45° field of view. 1932 by 1916 pixels
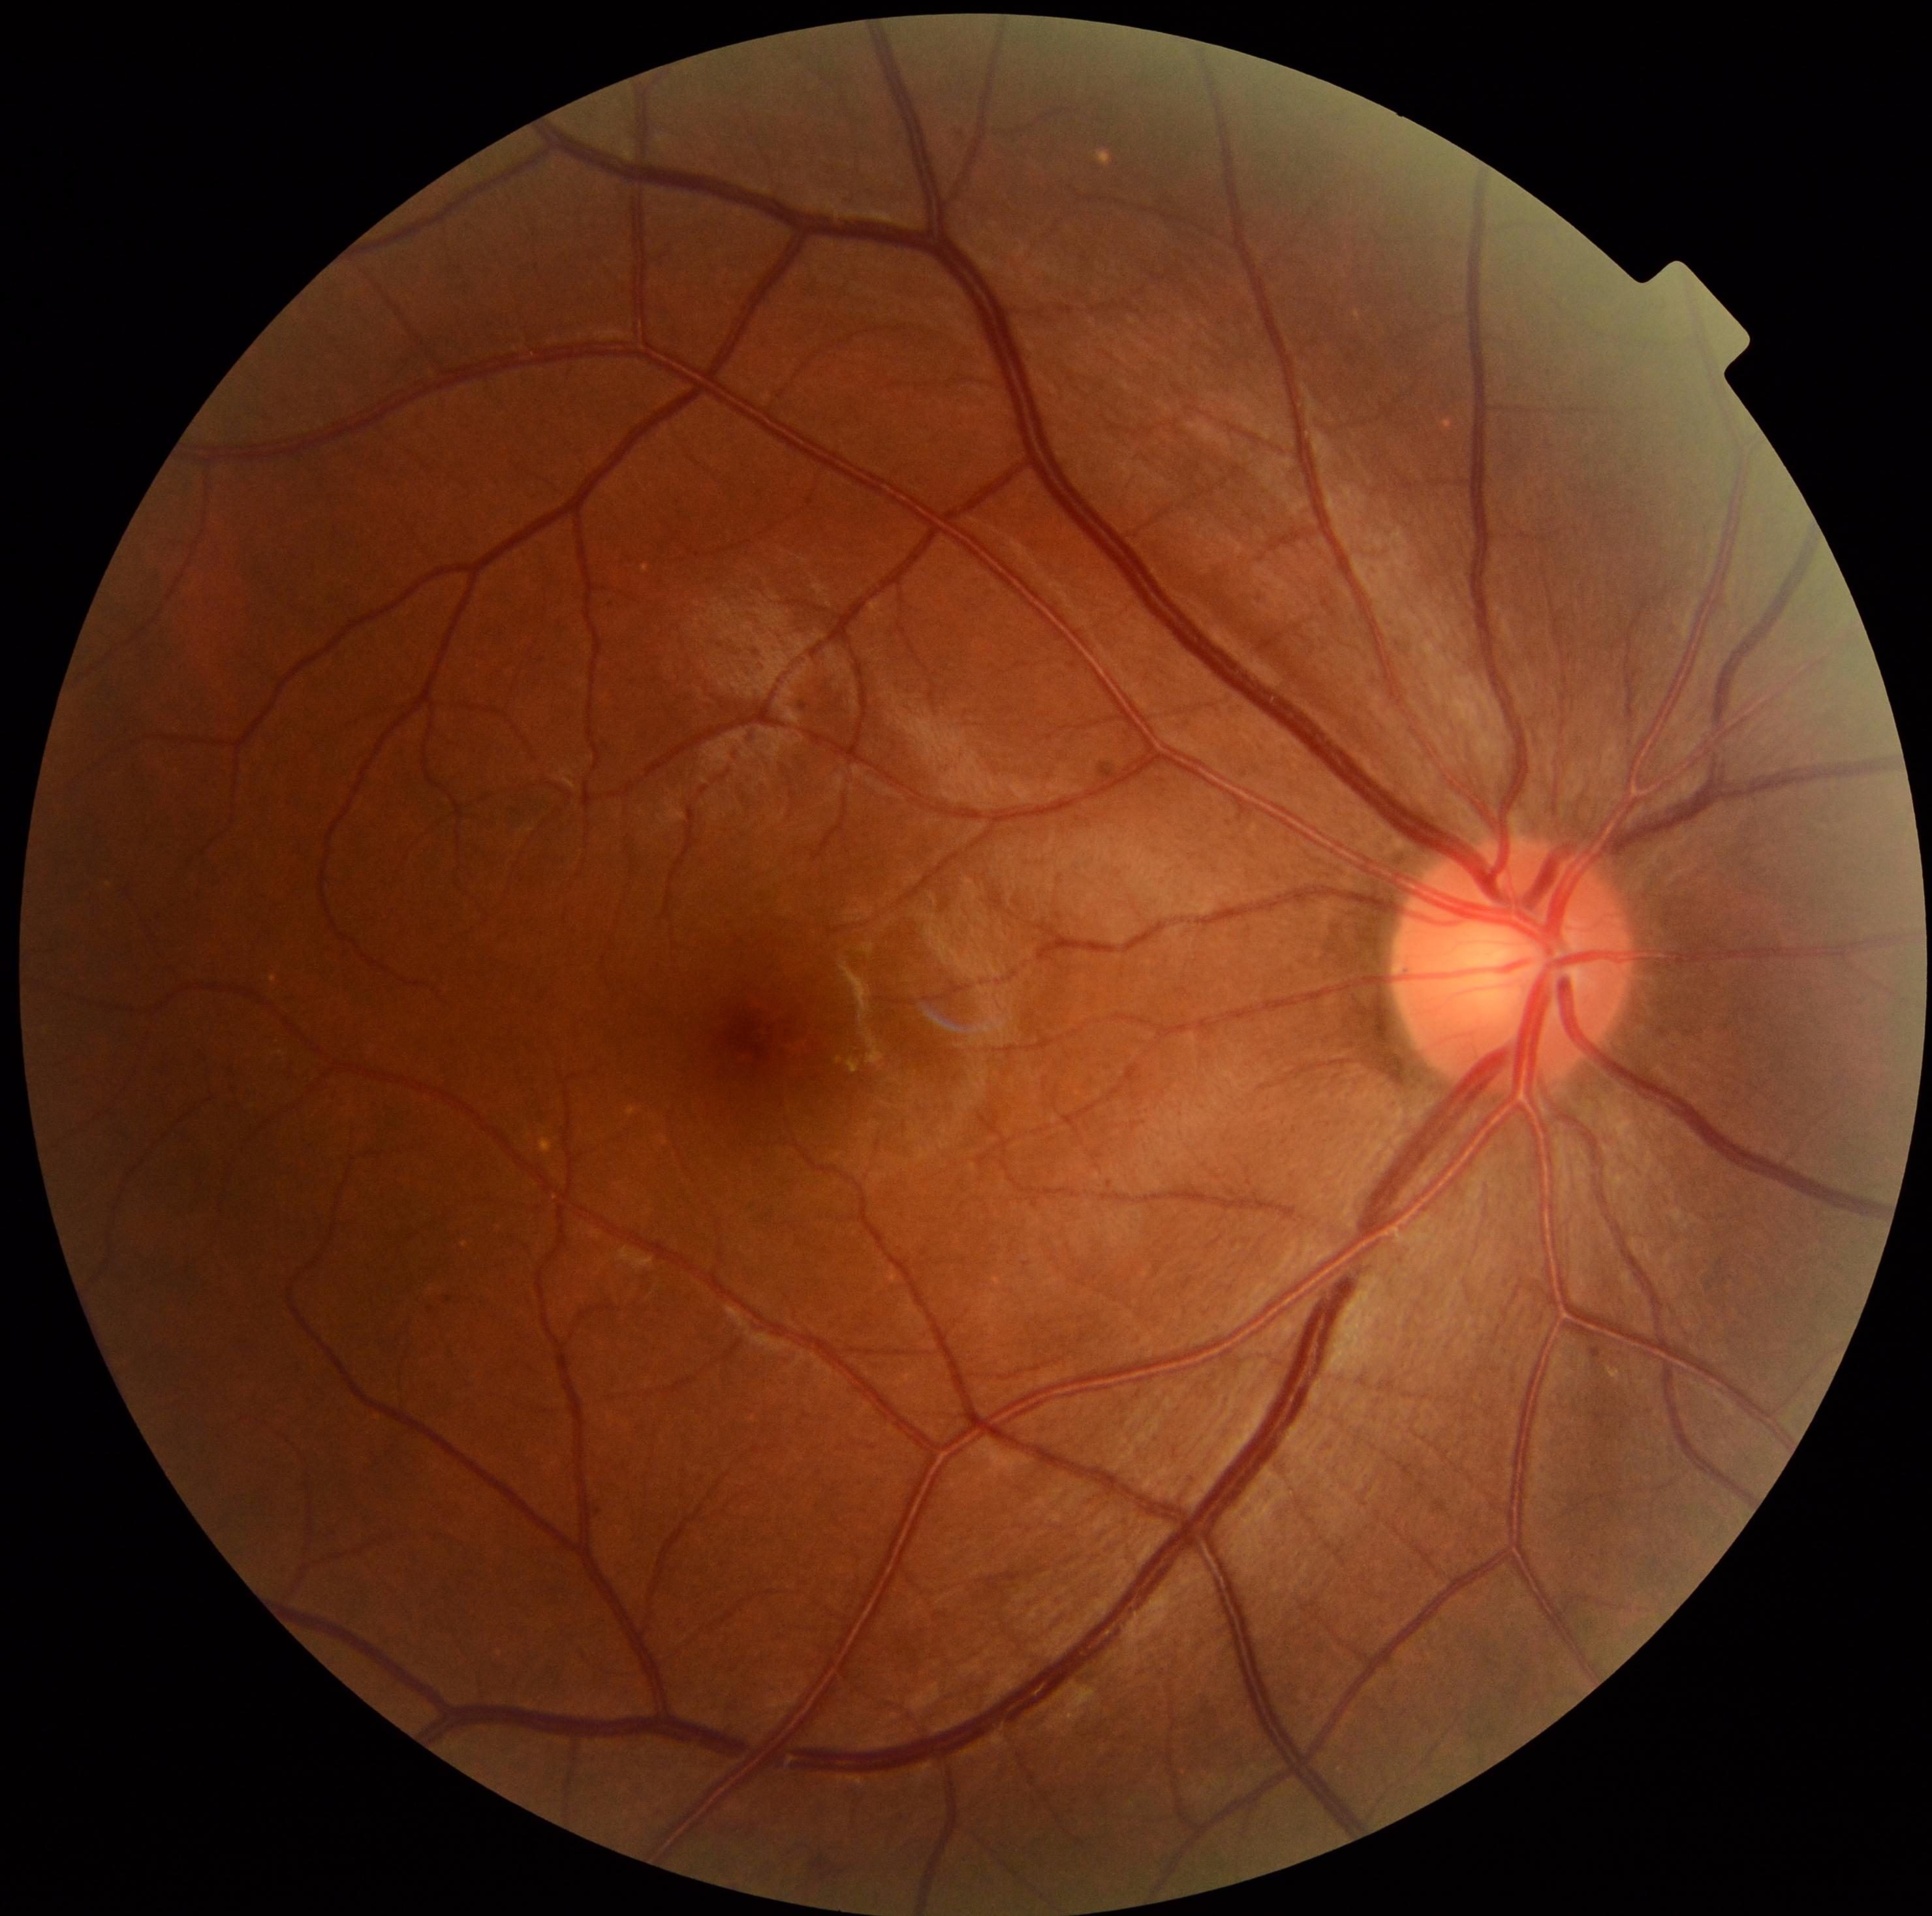

Findings:
- DR impression — negative for DR
- DR severity — 0